Color fundus photograph; captured without pupil dilation.
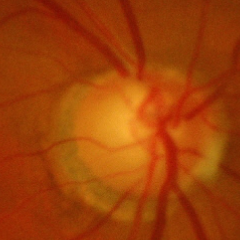

Q: Glaucoma assessment?
A: Yes — advanced glaucomatous optic neuropathy.